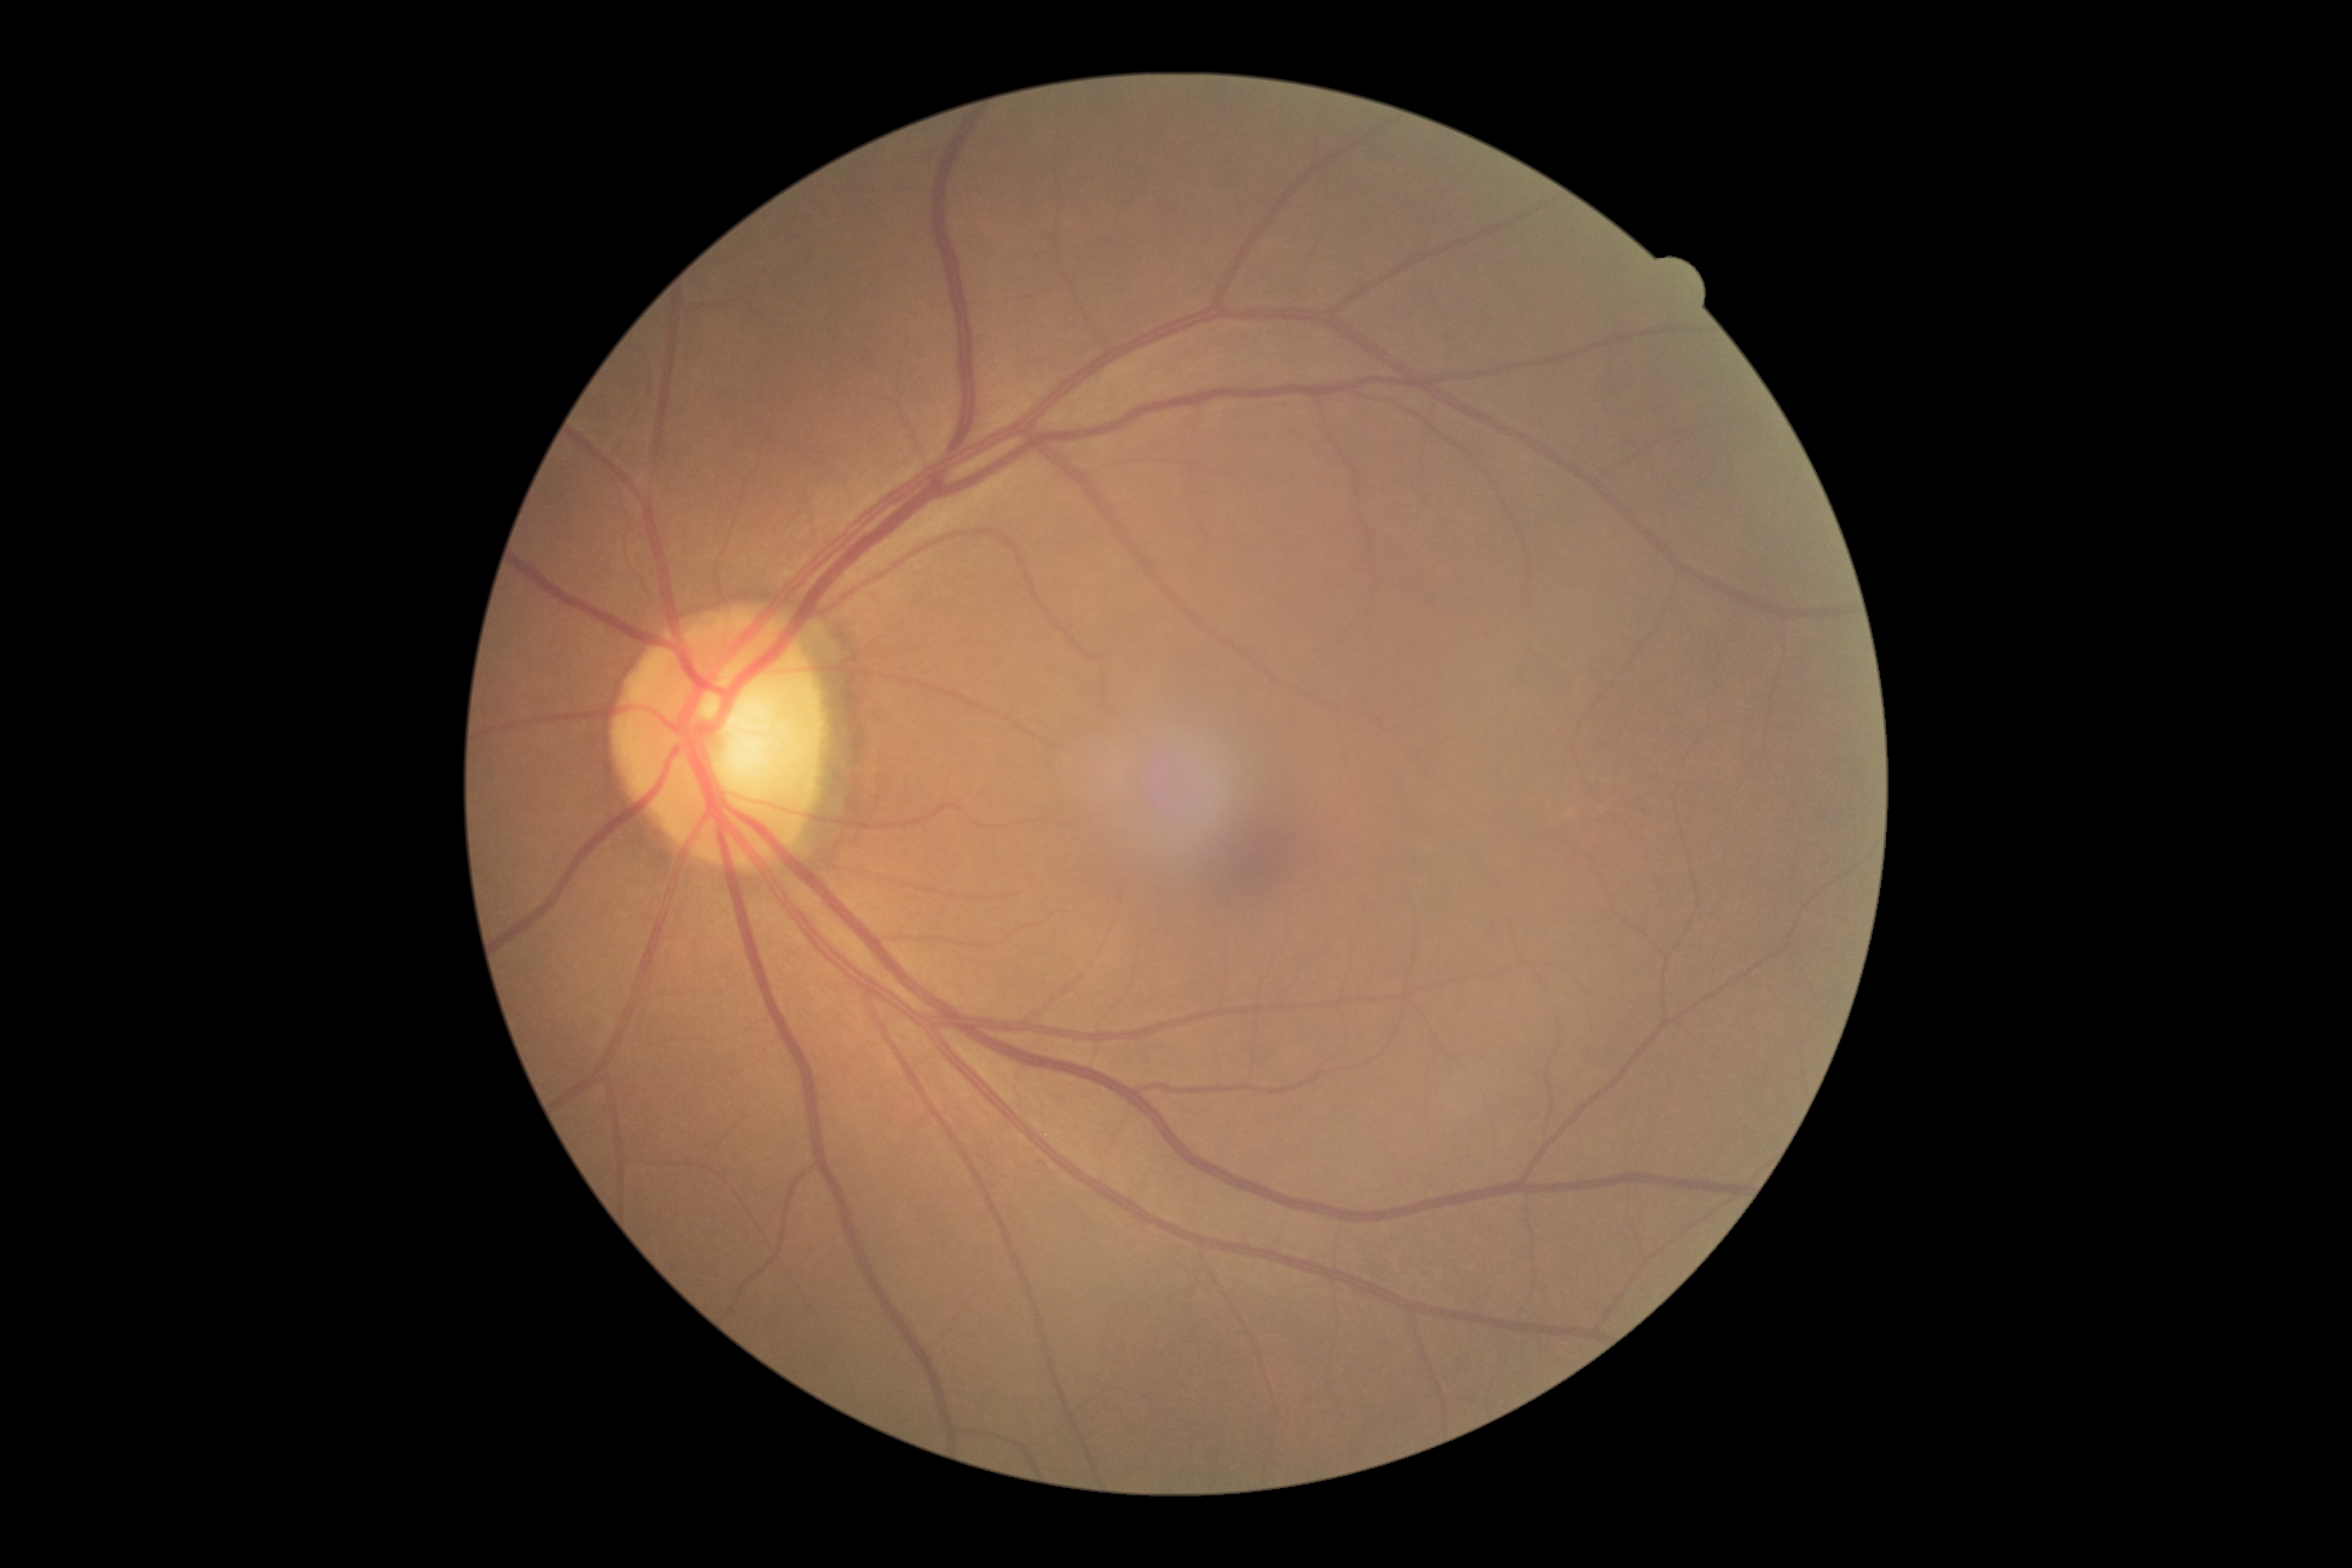 Diabetic retinopathy grade: 0 (no apparent retinopathy).
No diabetic retinal disease findings.